Retinal fundus photograph — 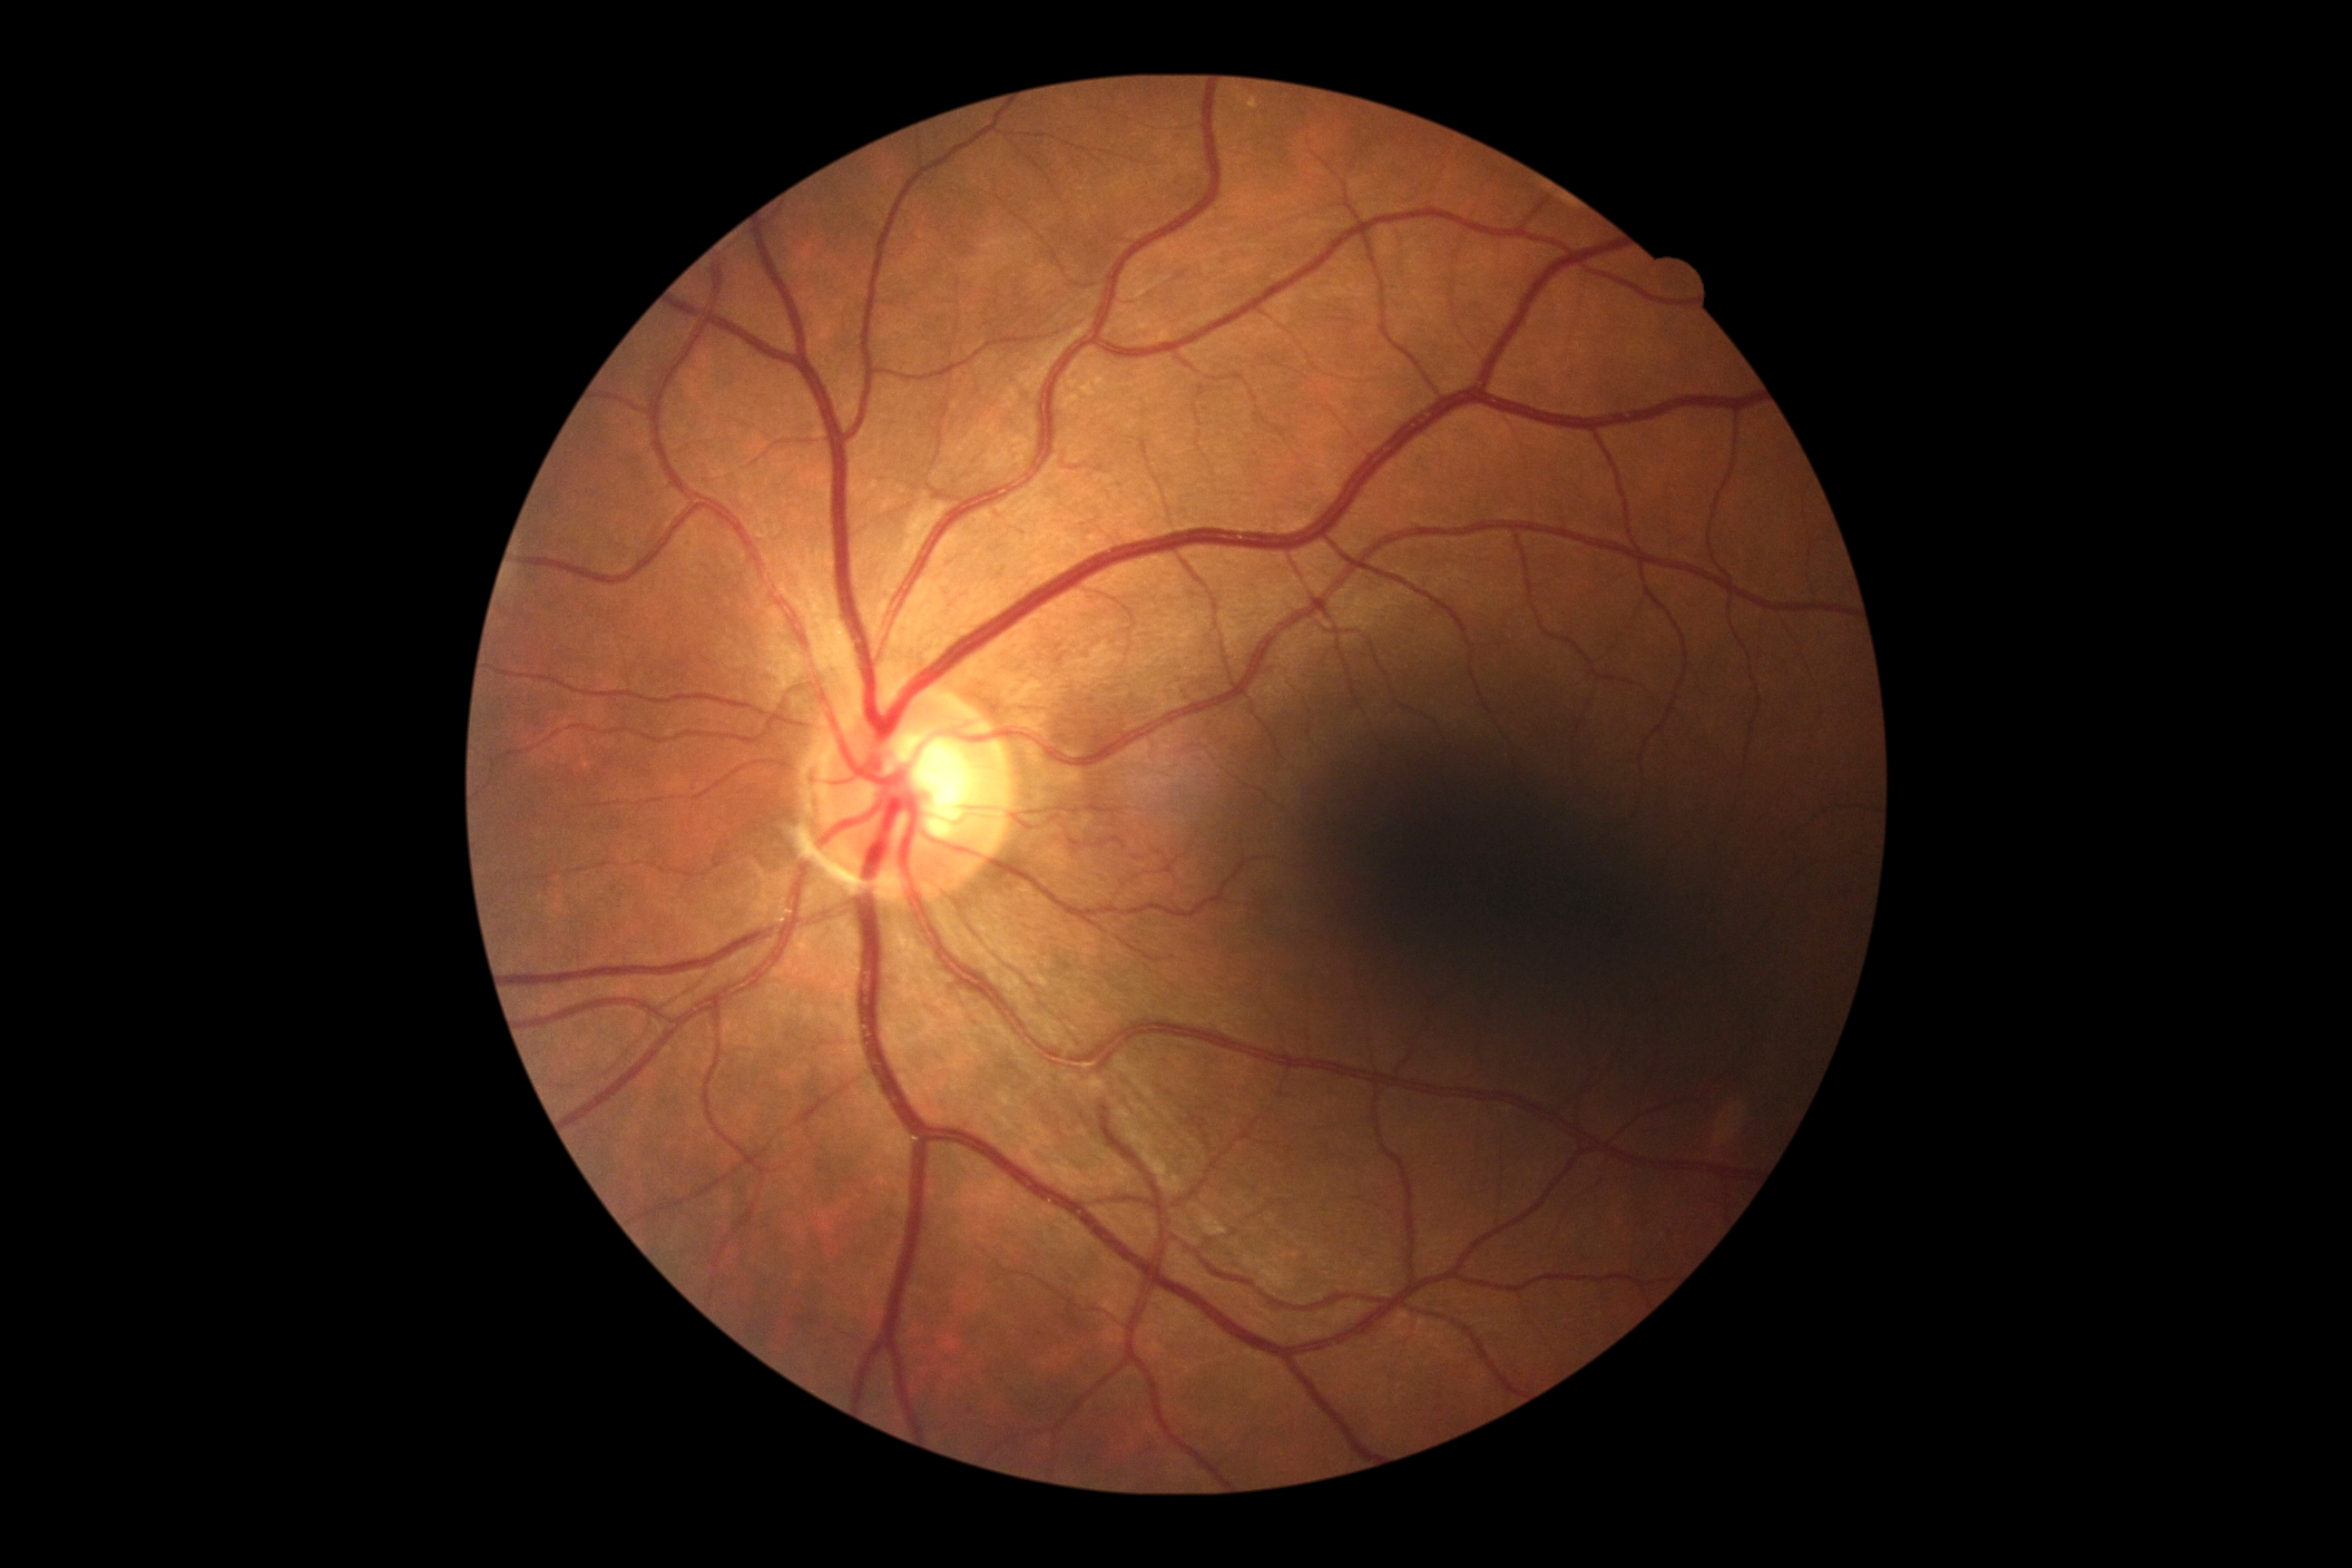

Diabetic retinopathy grade: 0/4.